Woman patient; 61 years old; non-mydriatic — 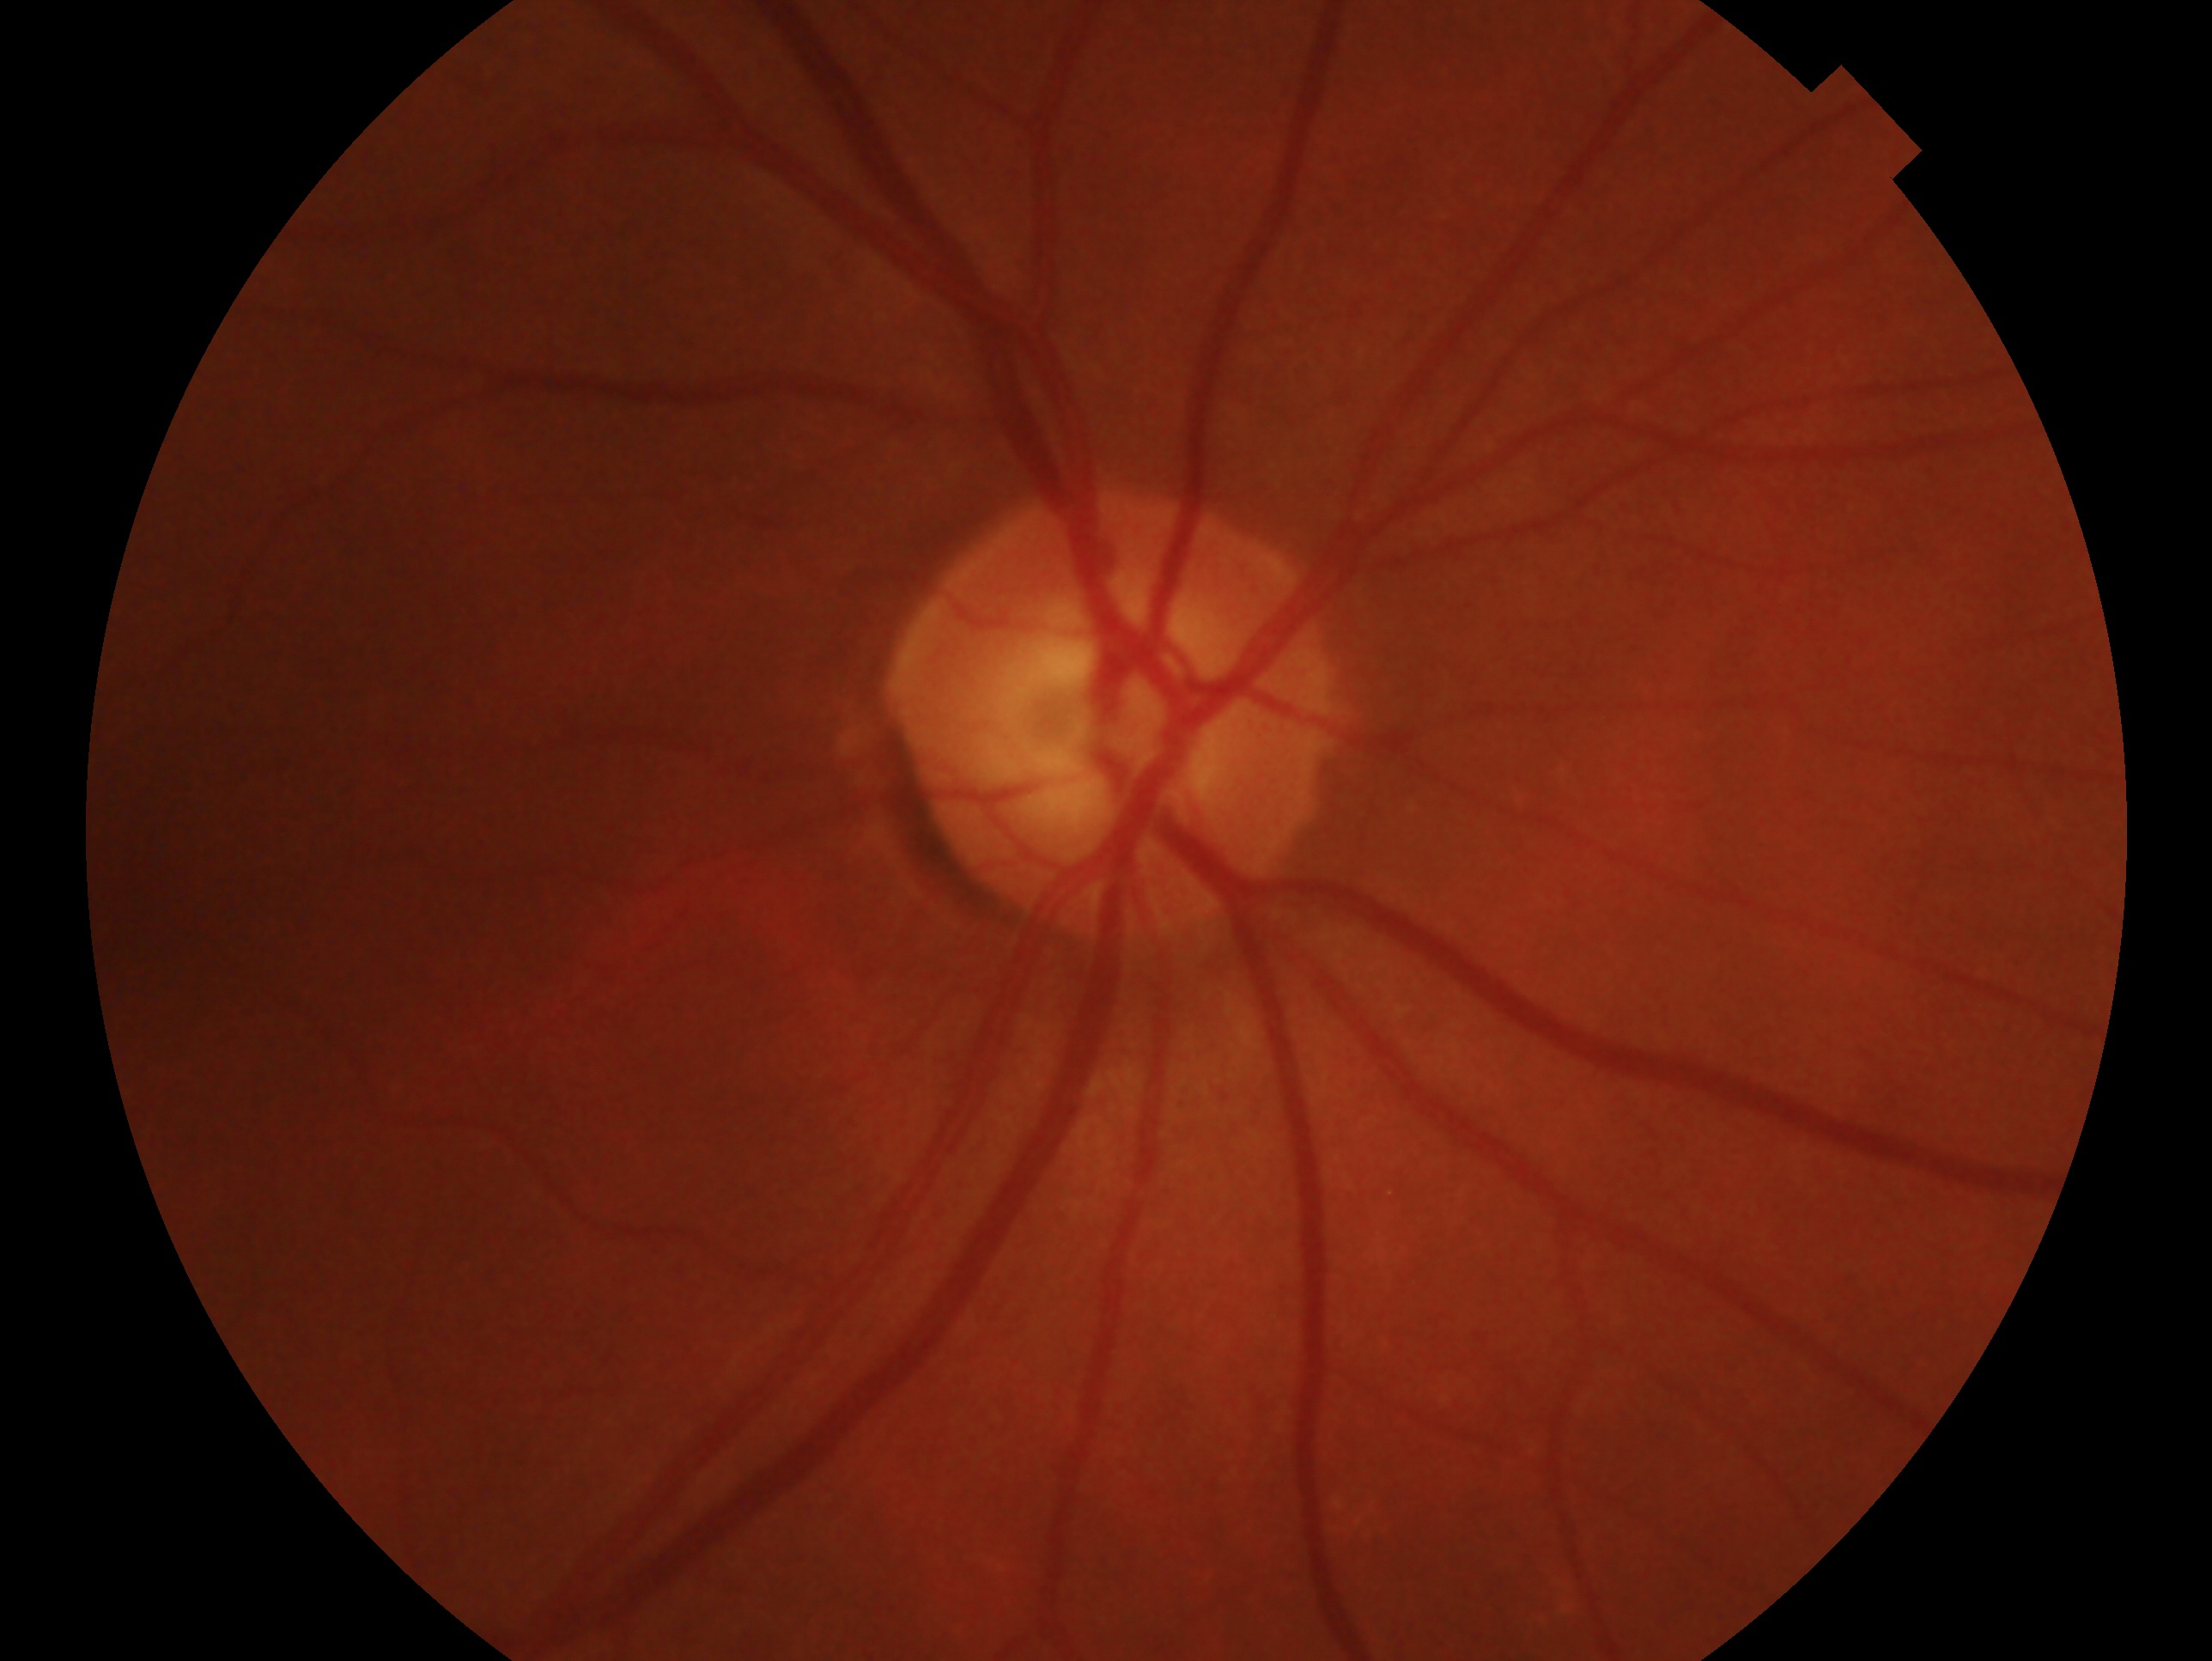
clinical classification=no evidence of glaucoma
eye=OD